Pediatric wide-field fundus photograph; 640x480; Clarity RetCam 3, 130° FOV.
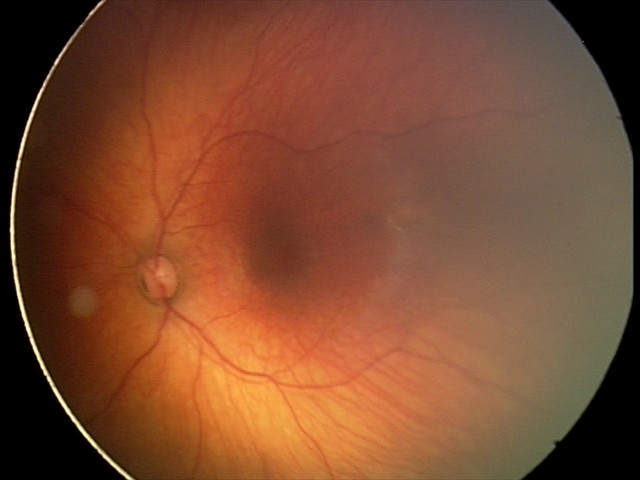

Series diagnosed as retinal hemorrhages.